Pediatric retinal photograph (wide-field) — 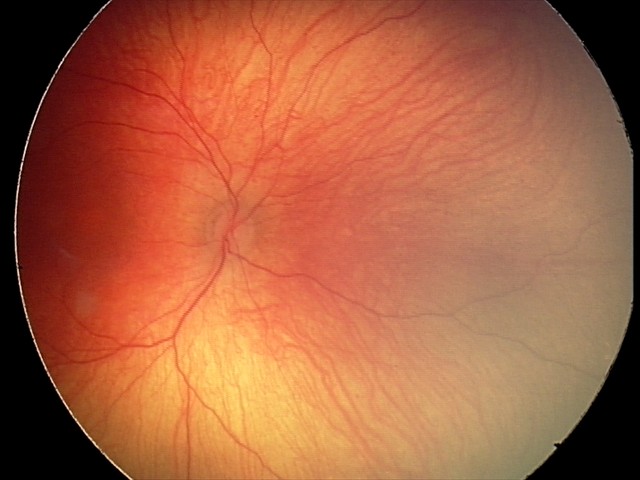
Screening diagnosis: normal retinal appearance.